NIDEK AFC-230:
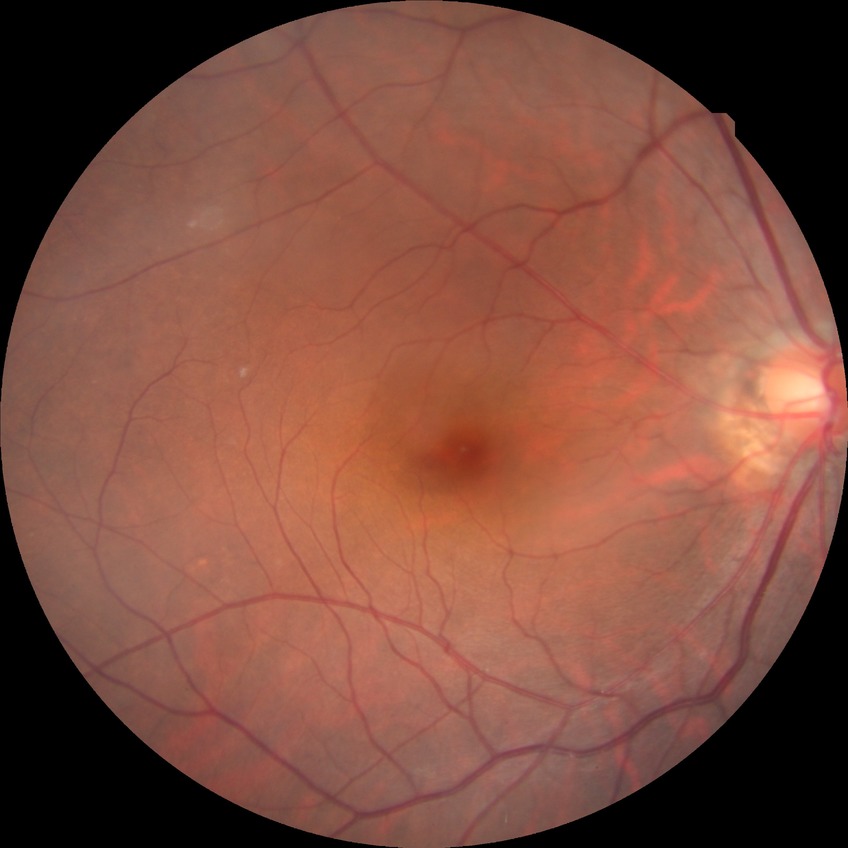 diabetic retinopathy severity = no diabetic retinopathy